Posterior pole color fundus photograph; 848x848; DR severity per modified Davis staging; NIDEK AFC-230 fundus camera:
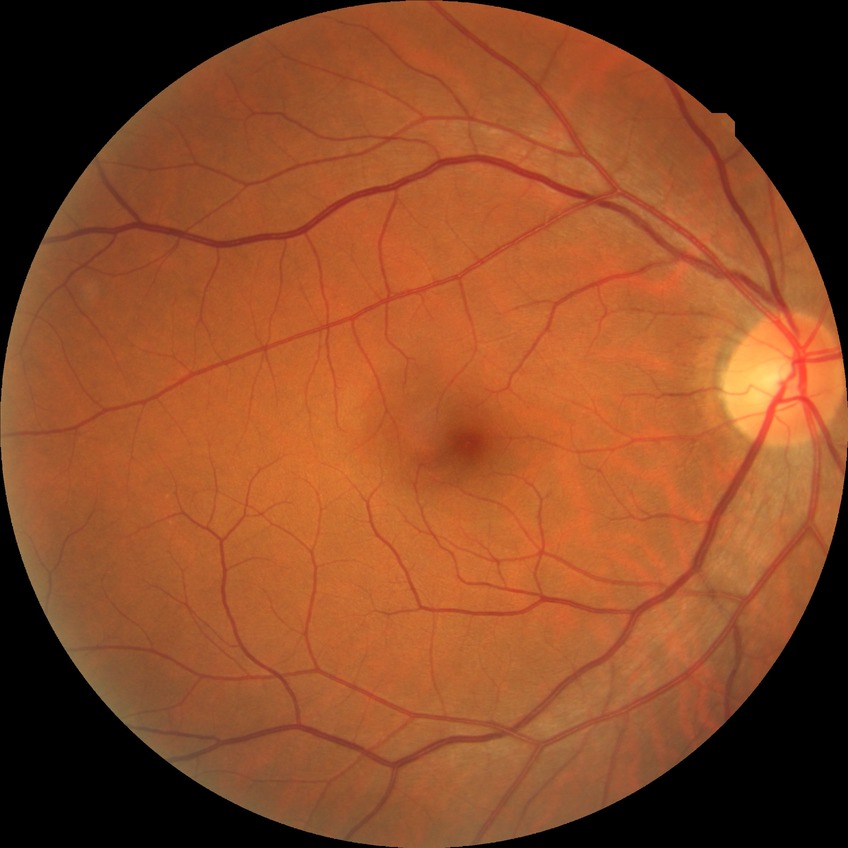
modified Davis grading=no diabetic retinopathy.